Pediatric wide-field fundus photograph.
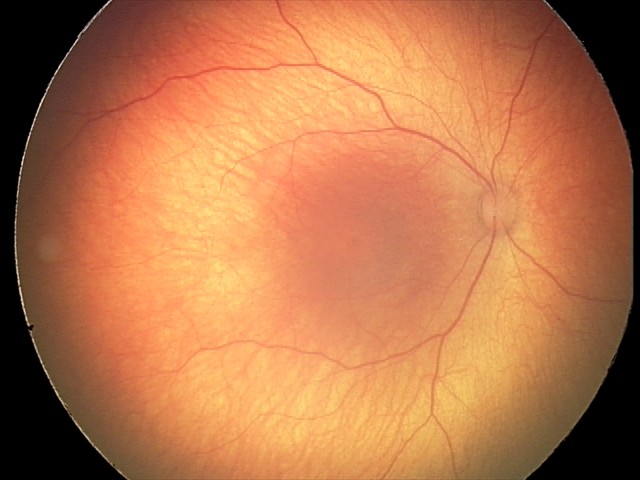 Examination with physiological retinal findings.